640x480; wide-field fundus photograph from neonatal ROP screening:
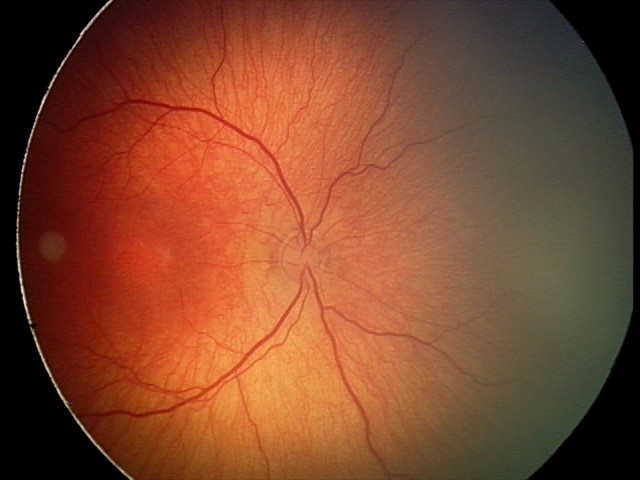 Diagnosis = retinopathy of prematurity (ROP) stage 2
plus form = absent